Fundus photo; captured on a Remidio smartphone fundus camera.
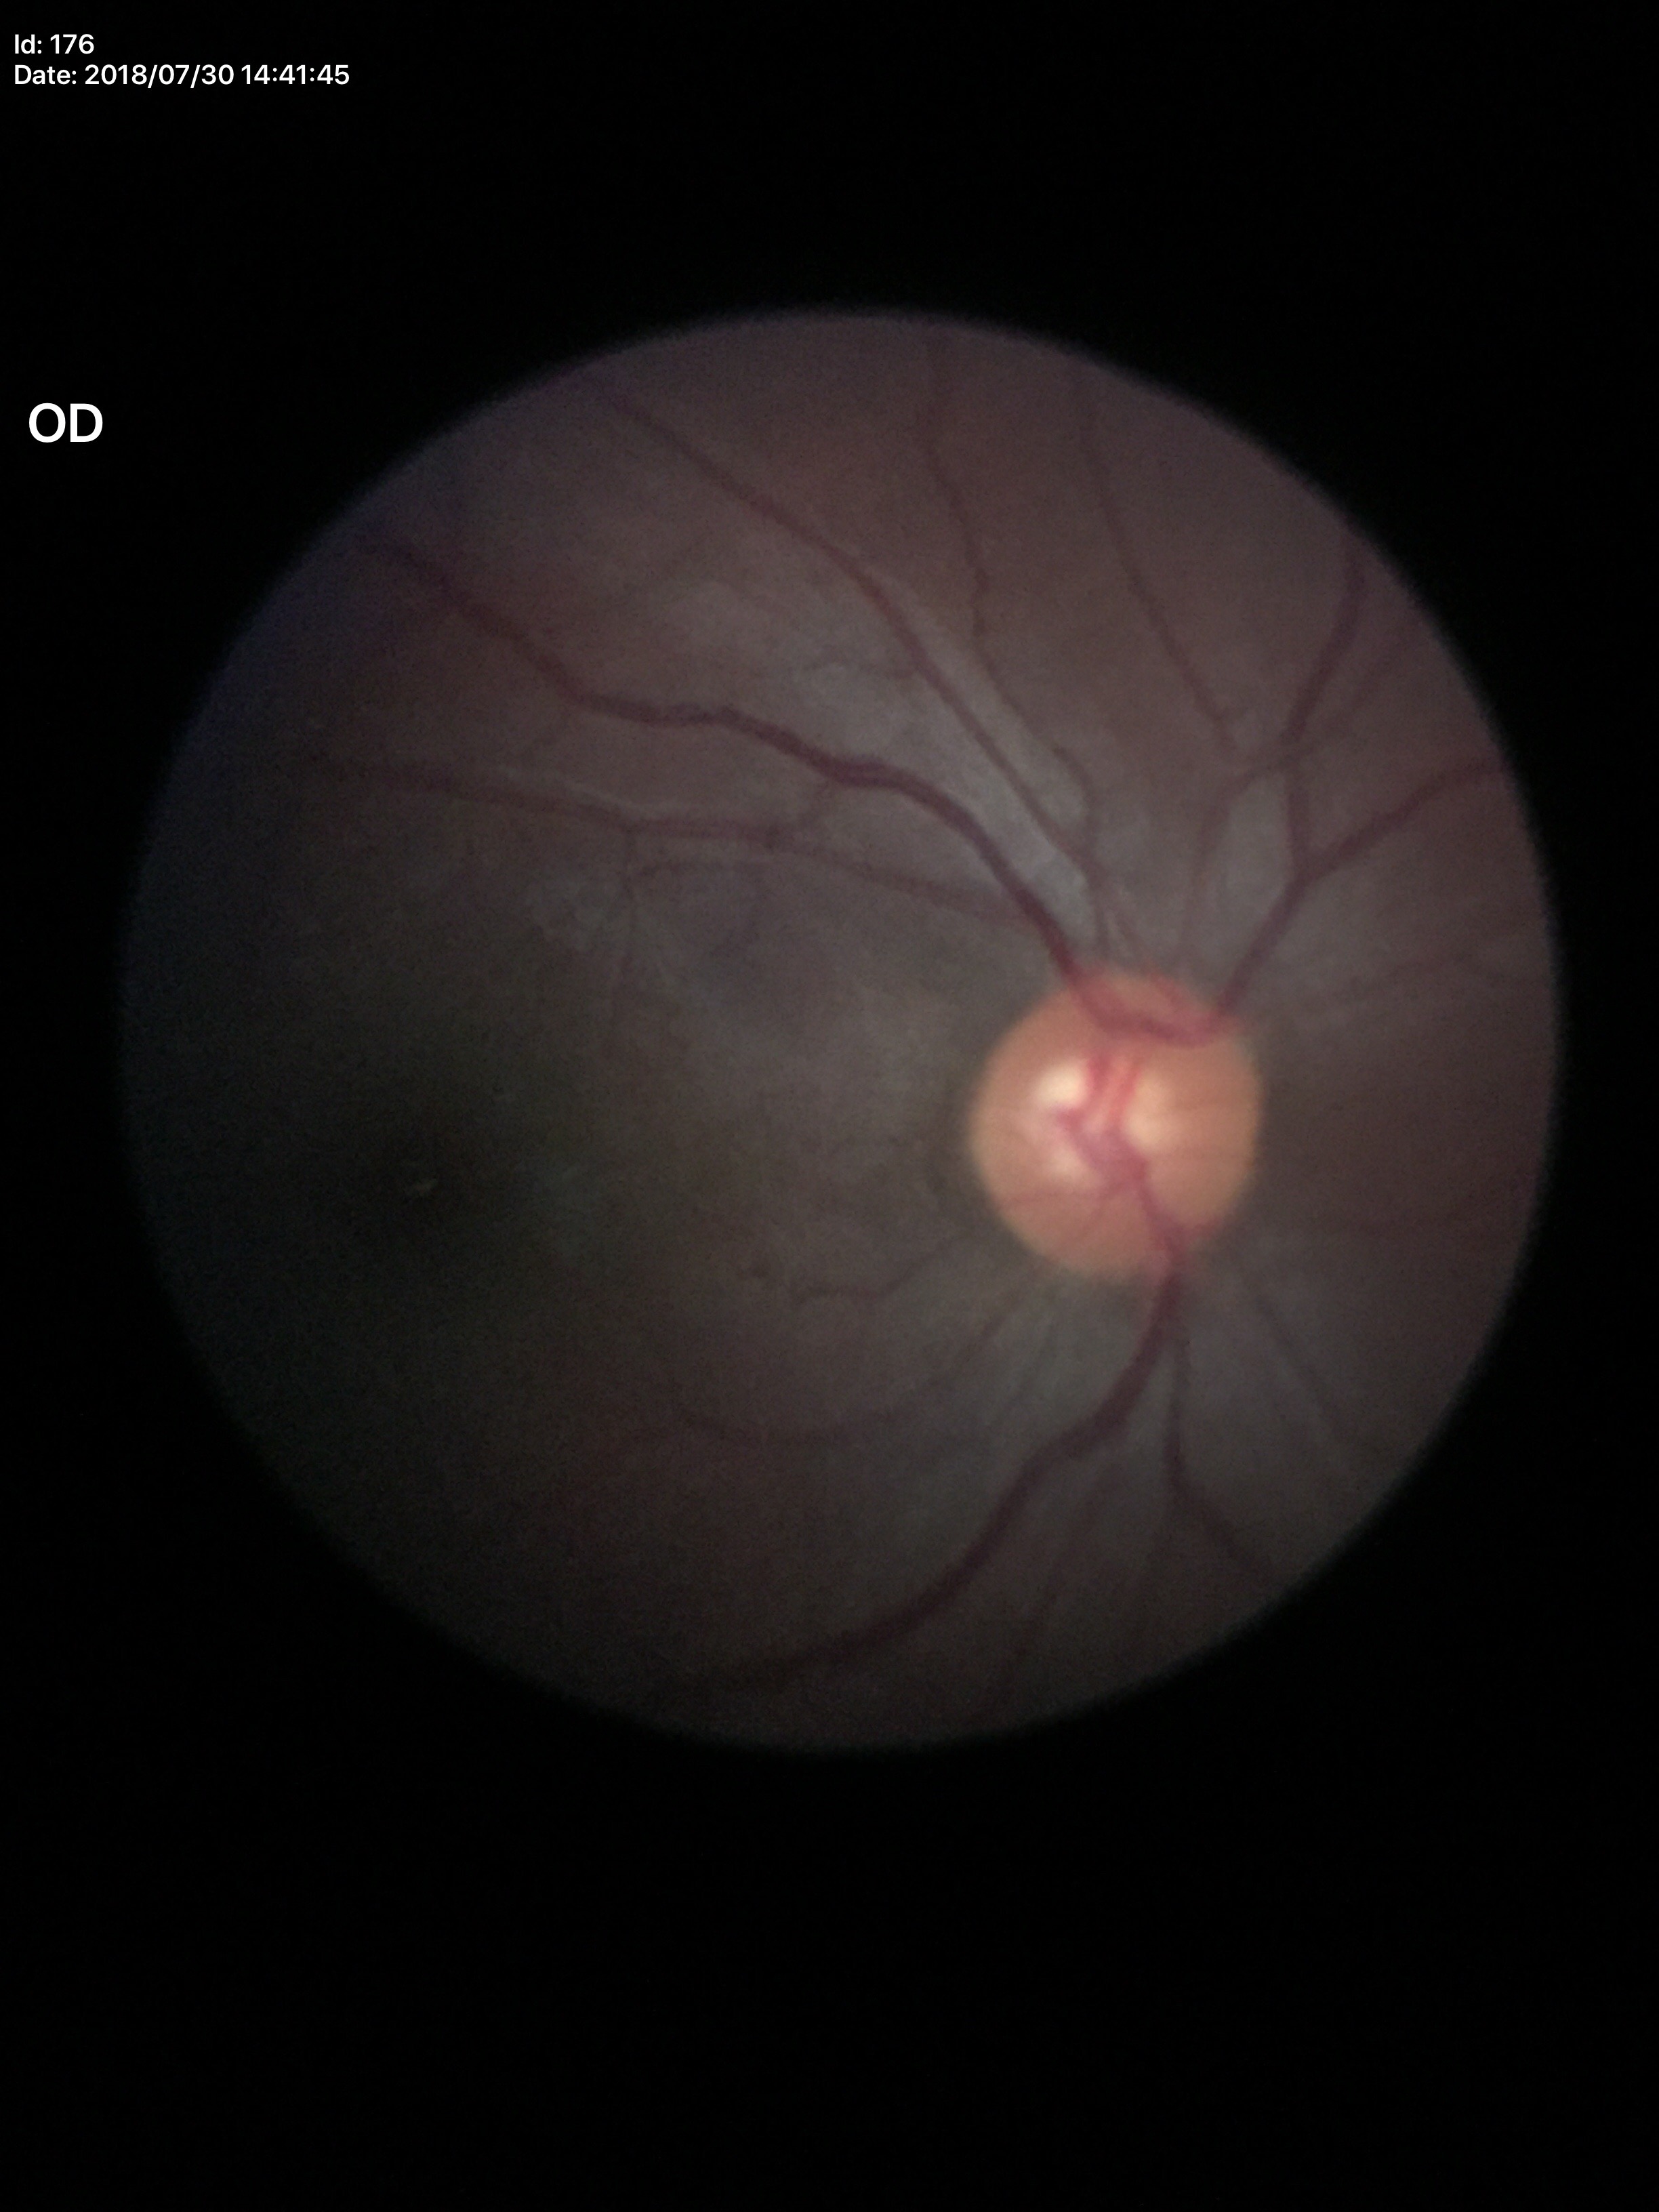
Glaucoma evaluation = negative (1/5 graders called glaucoma suspect) | vertical cup-disc ratio (VCDR) = 0.55.